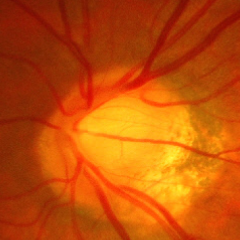
Glaucomatous optic neuropathy is present. Glaucoma assessment = advanced glaucomatous optic neuropathy. (Criteria: near-total cupping of the optic nerve head, with or without severe visual field loss within the central 10 degrees of fixation.)